1240x1240px. Phoenix ICON wide-field infant fundus image. Captured with the Phoenix ICON (100° field of view)
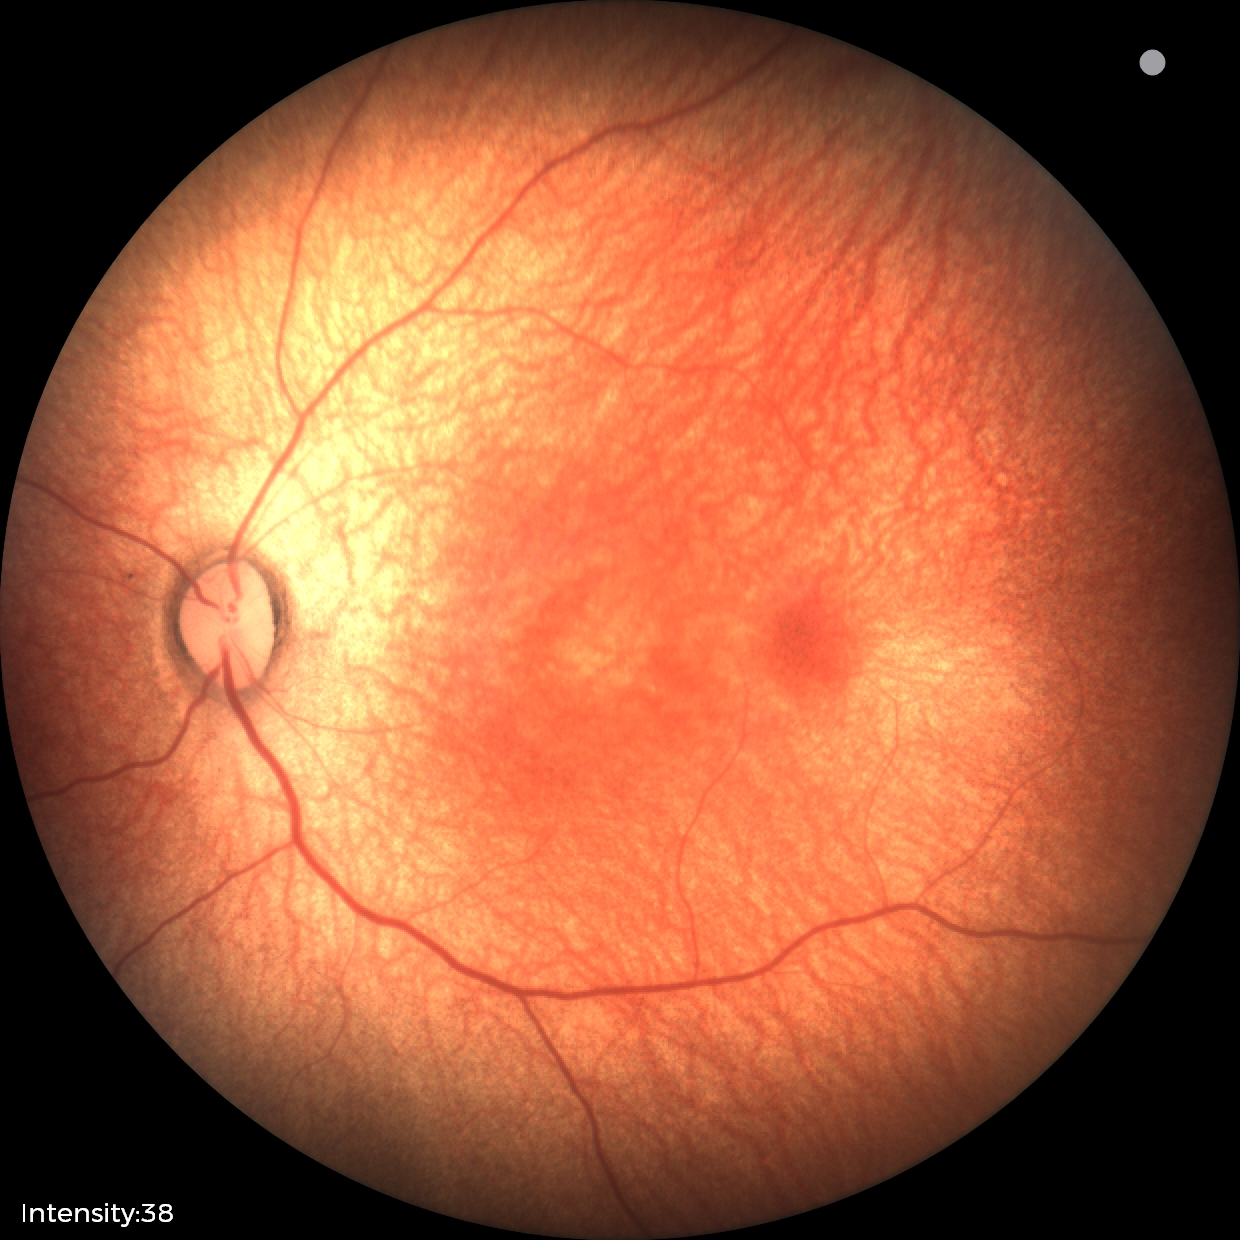
Screening examination diagnosed as physiological.